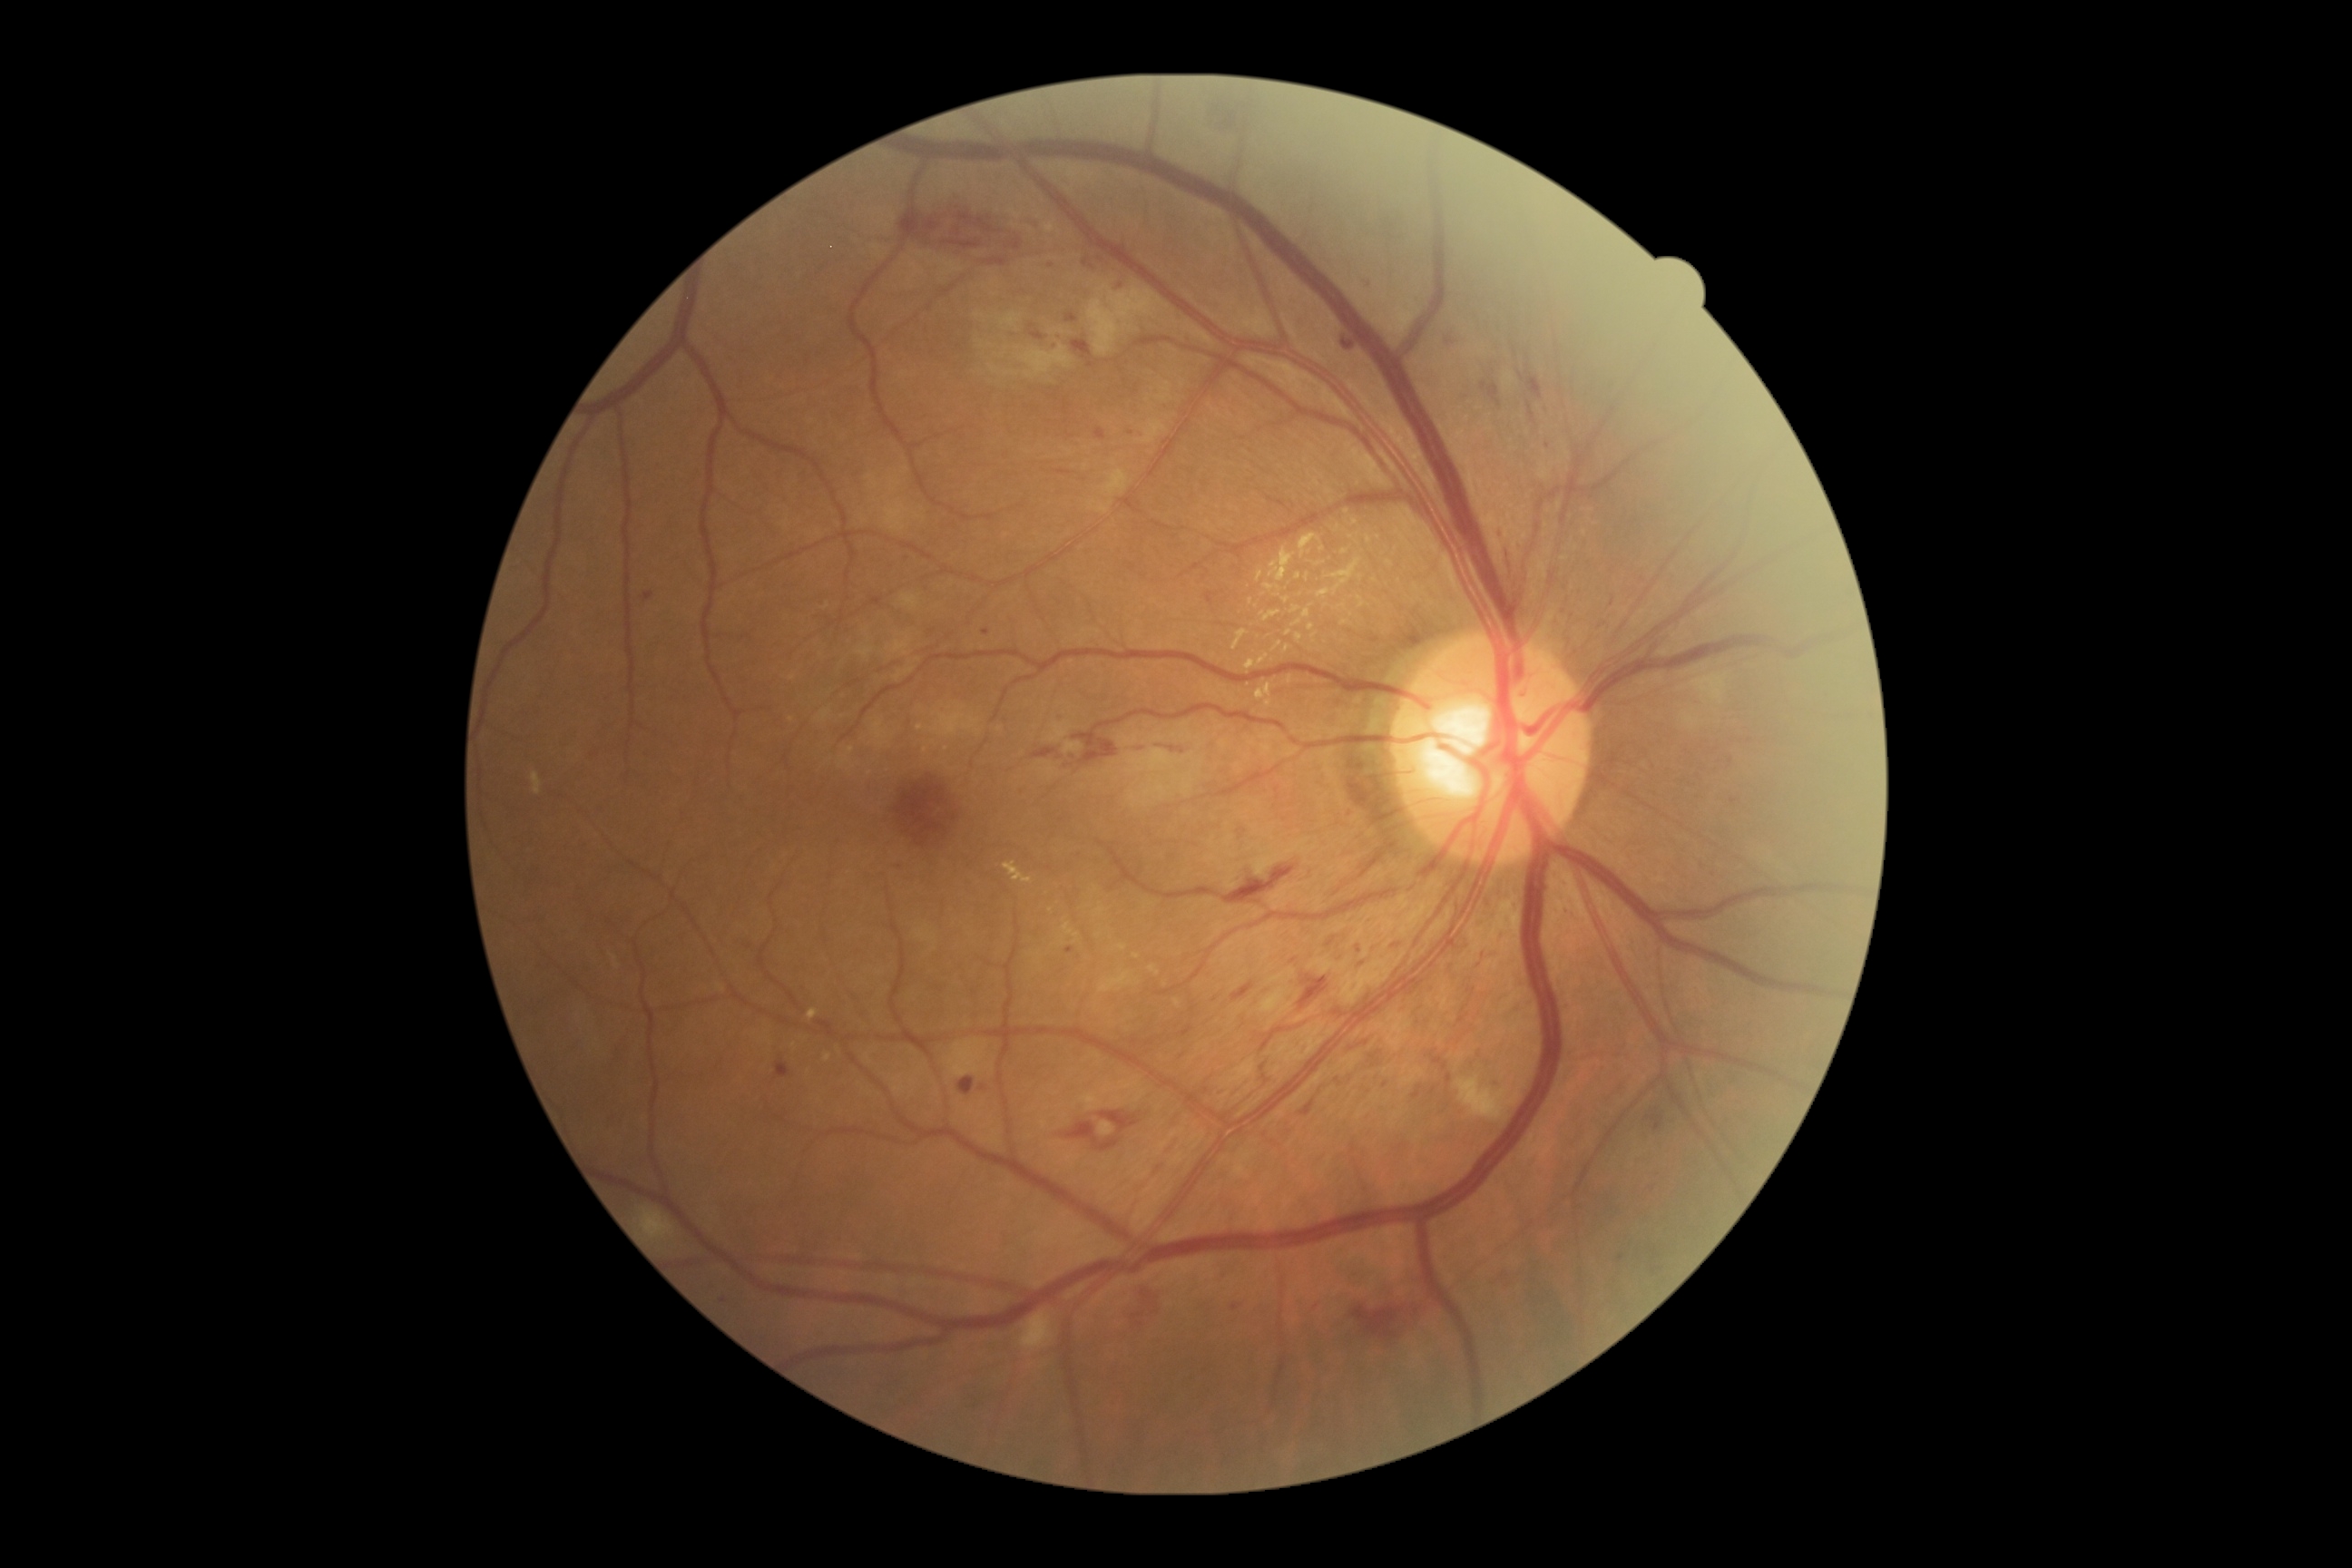

DR stage is 2.